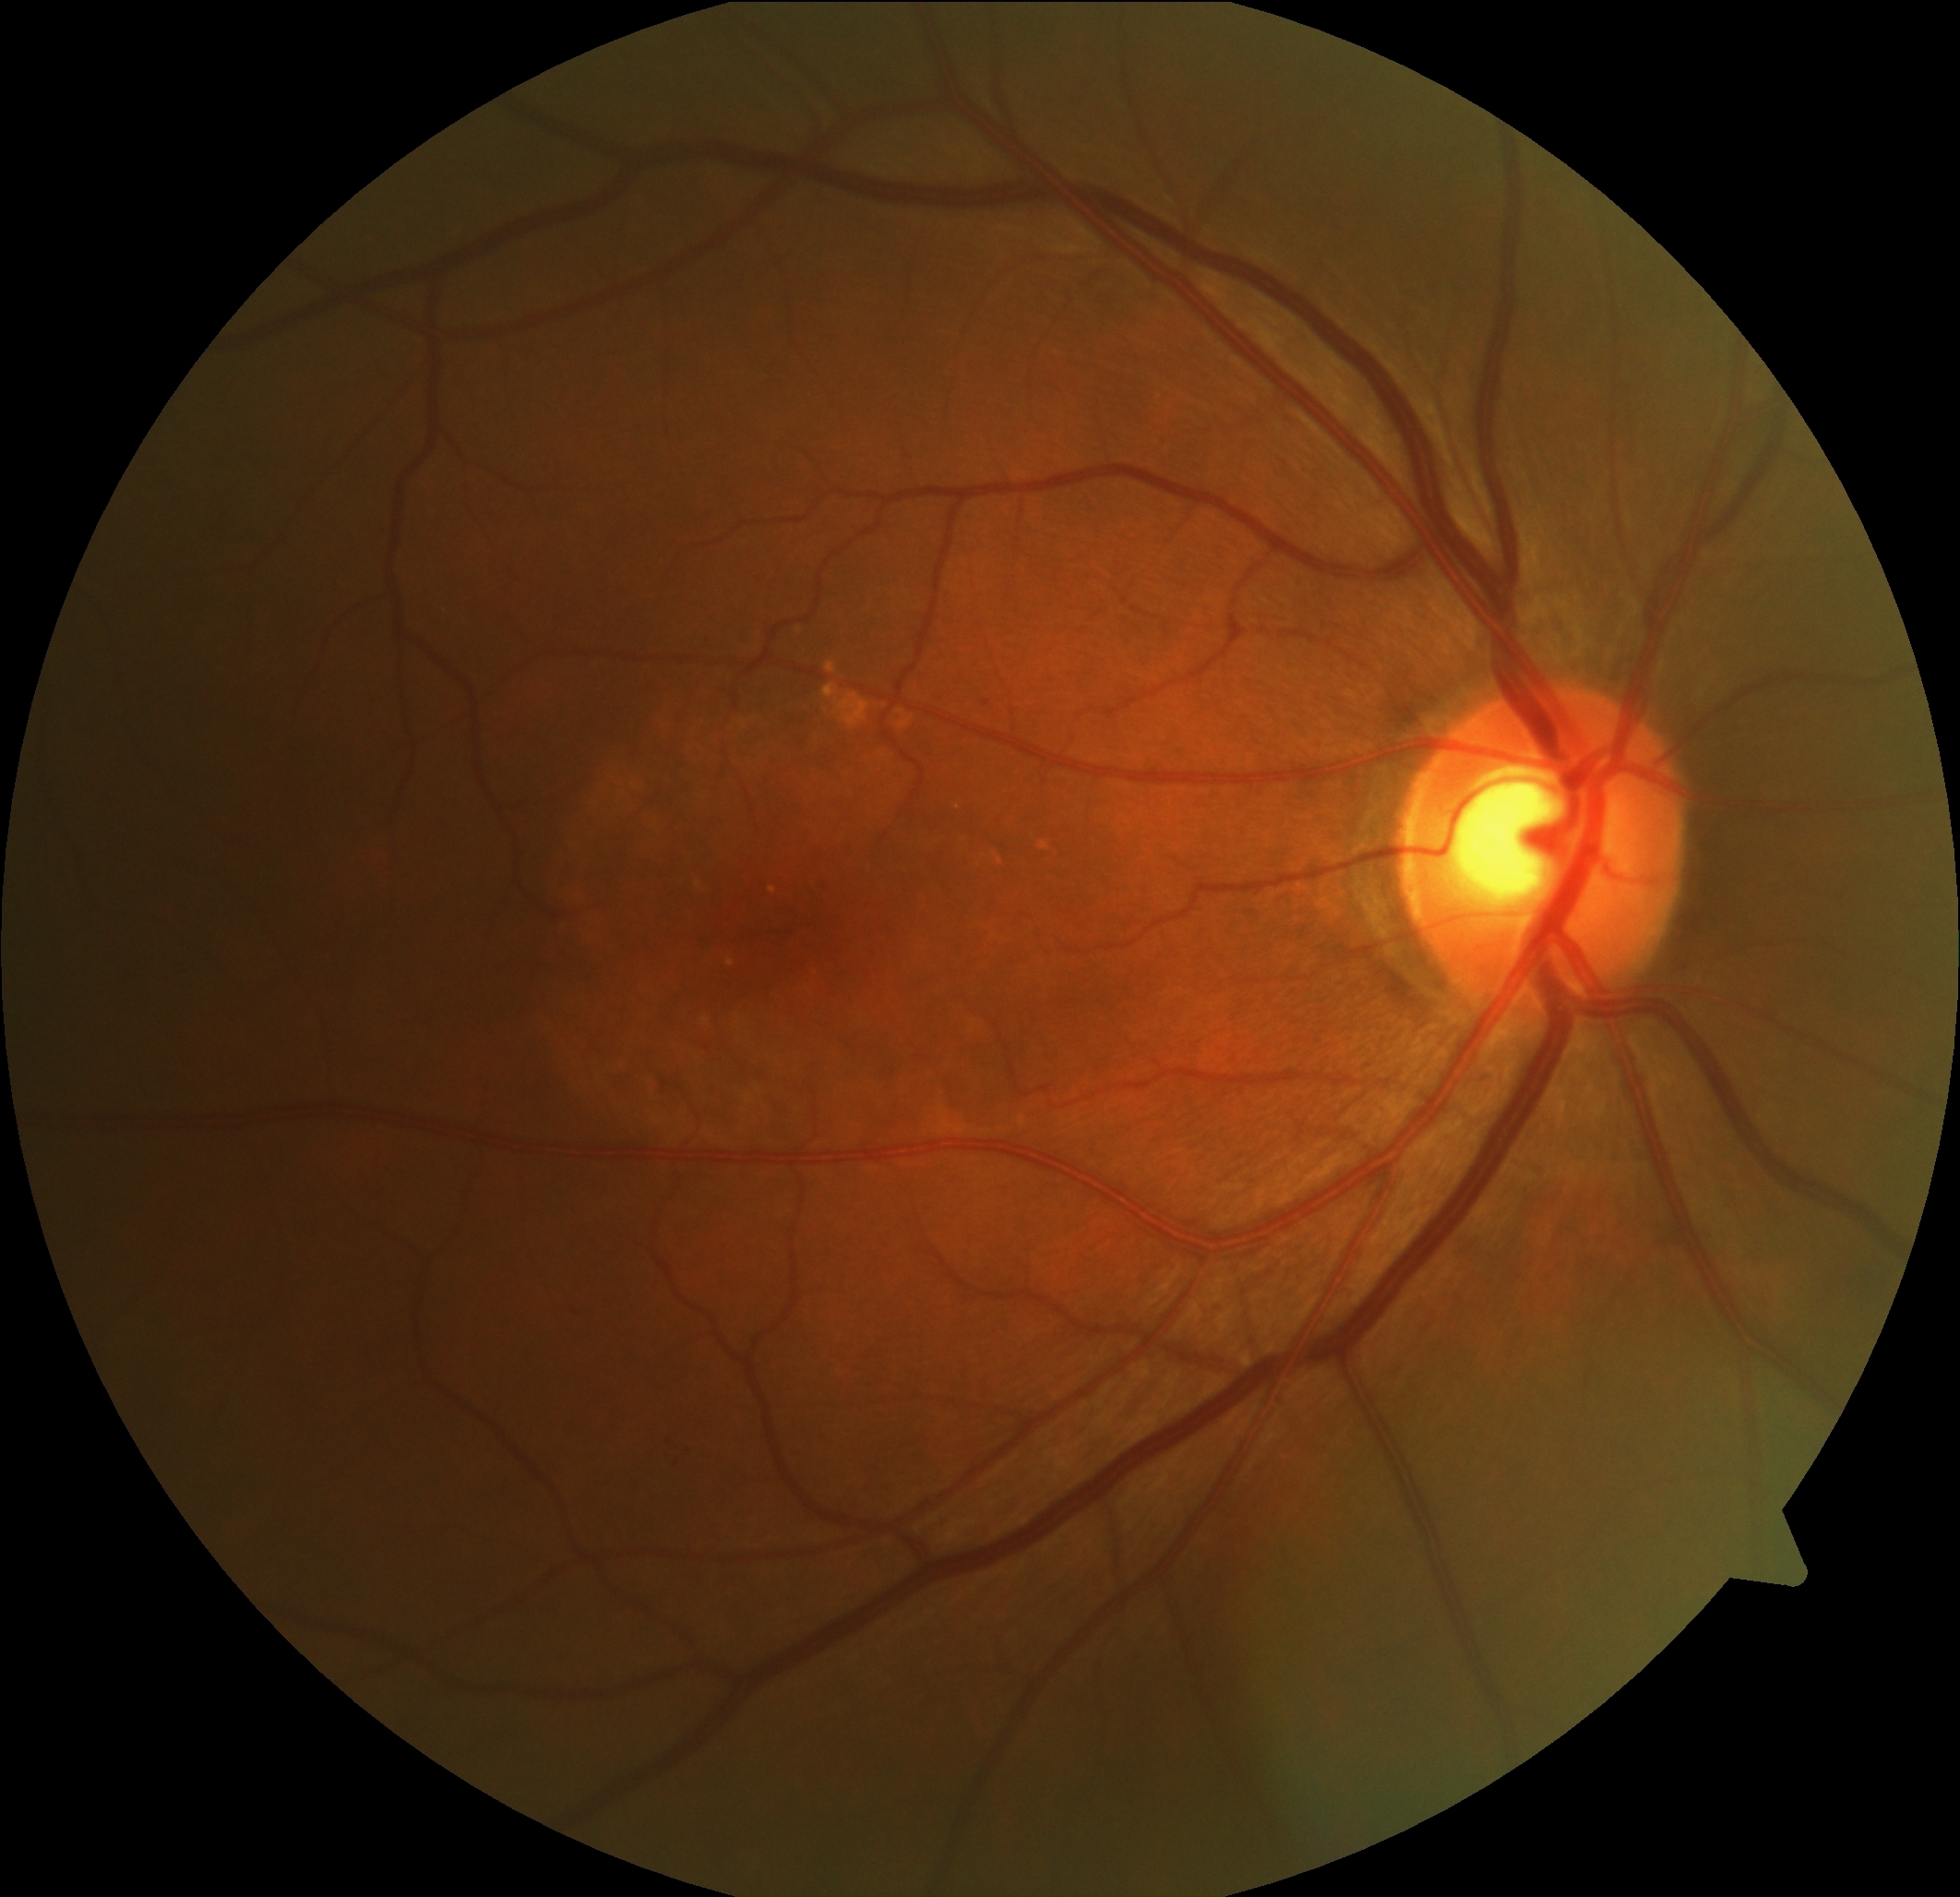

DR: grade 1 (mild NPDR); non-proliferative diabetic retinopathy
Lesions identified (partial list):
EXs: none detected
HEs: bbox=[572, 1303, 586, 1313]
SEs: none detected
MAs (partial): bbox=[984, 699, 991, 708]
Small MAs approximately at pt(670, 1441) | pt(681, 1441) | pt(708, 1048)